Camera: NIDEK AFC-230. 45° field of view. No pharmacologic dilation — 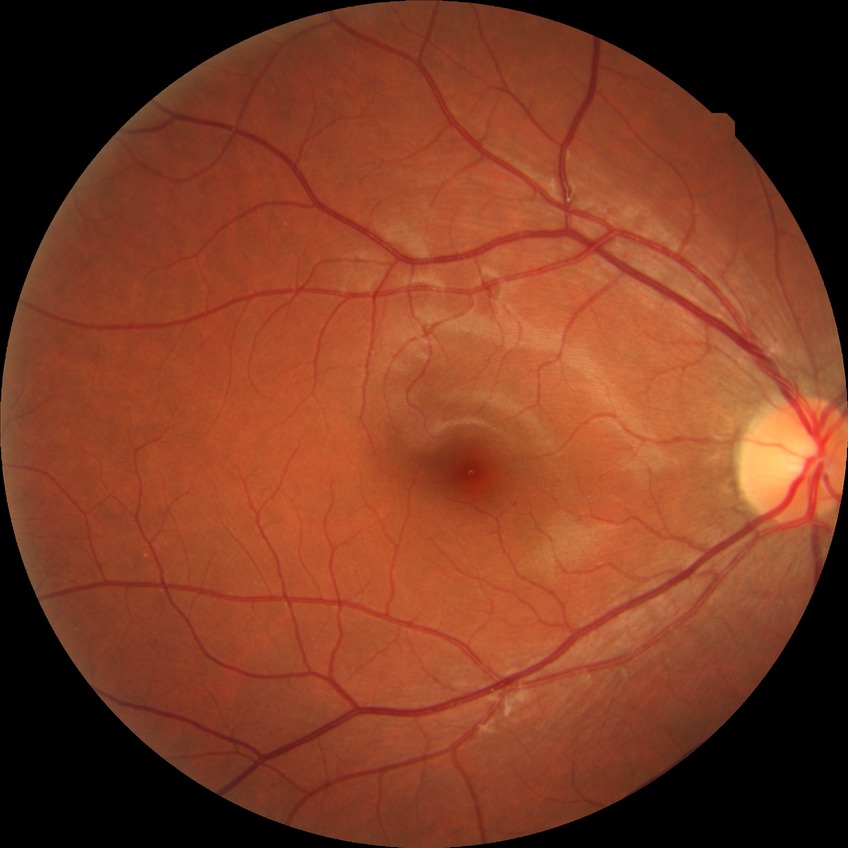 Modified Davis classification: no diabetic retinopathy.